NIDEK AFC-230 fundus camera; 45 degree fundus photograph; DR severity per modified Davis staging
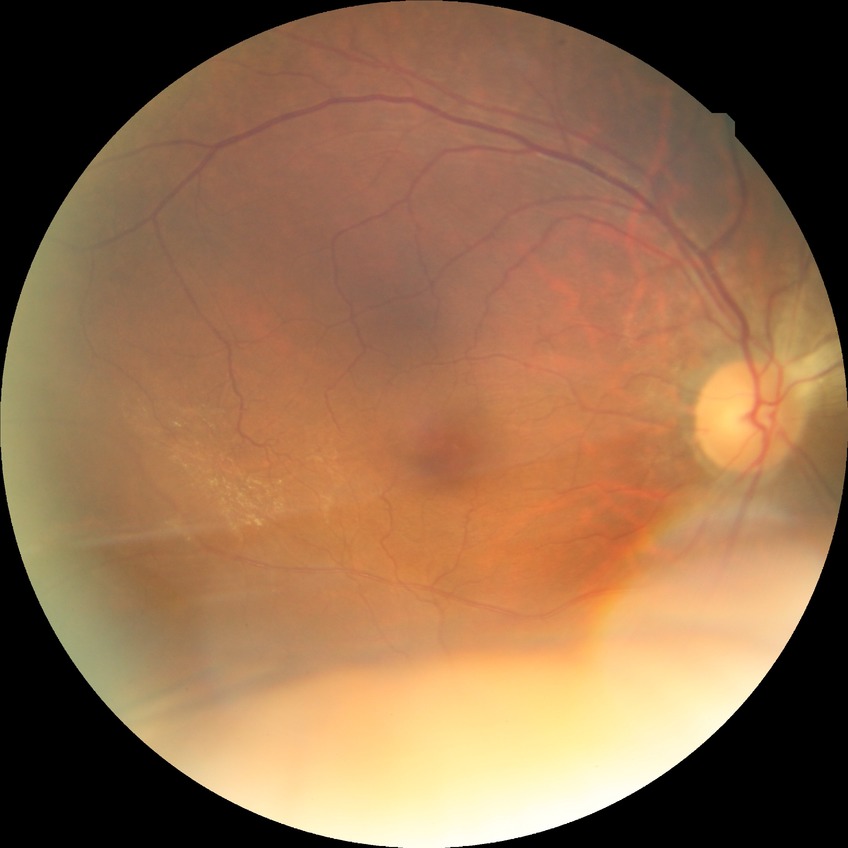

diabetic retinopathy (DR) = NDR (no diabetic retinopathy).